2184 x 1690 pixels.
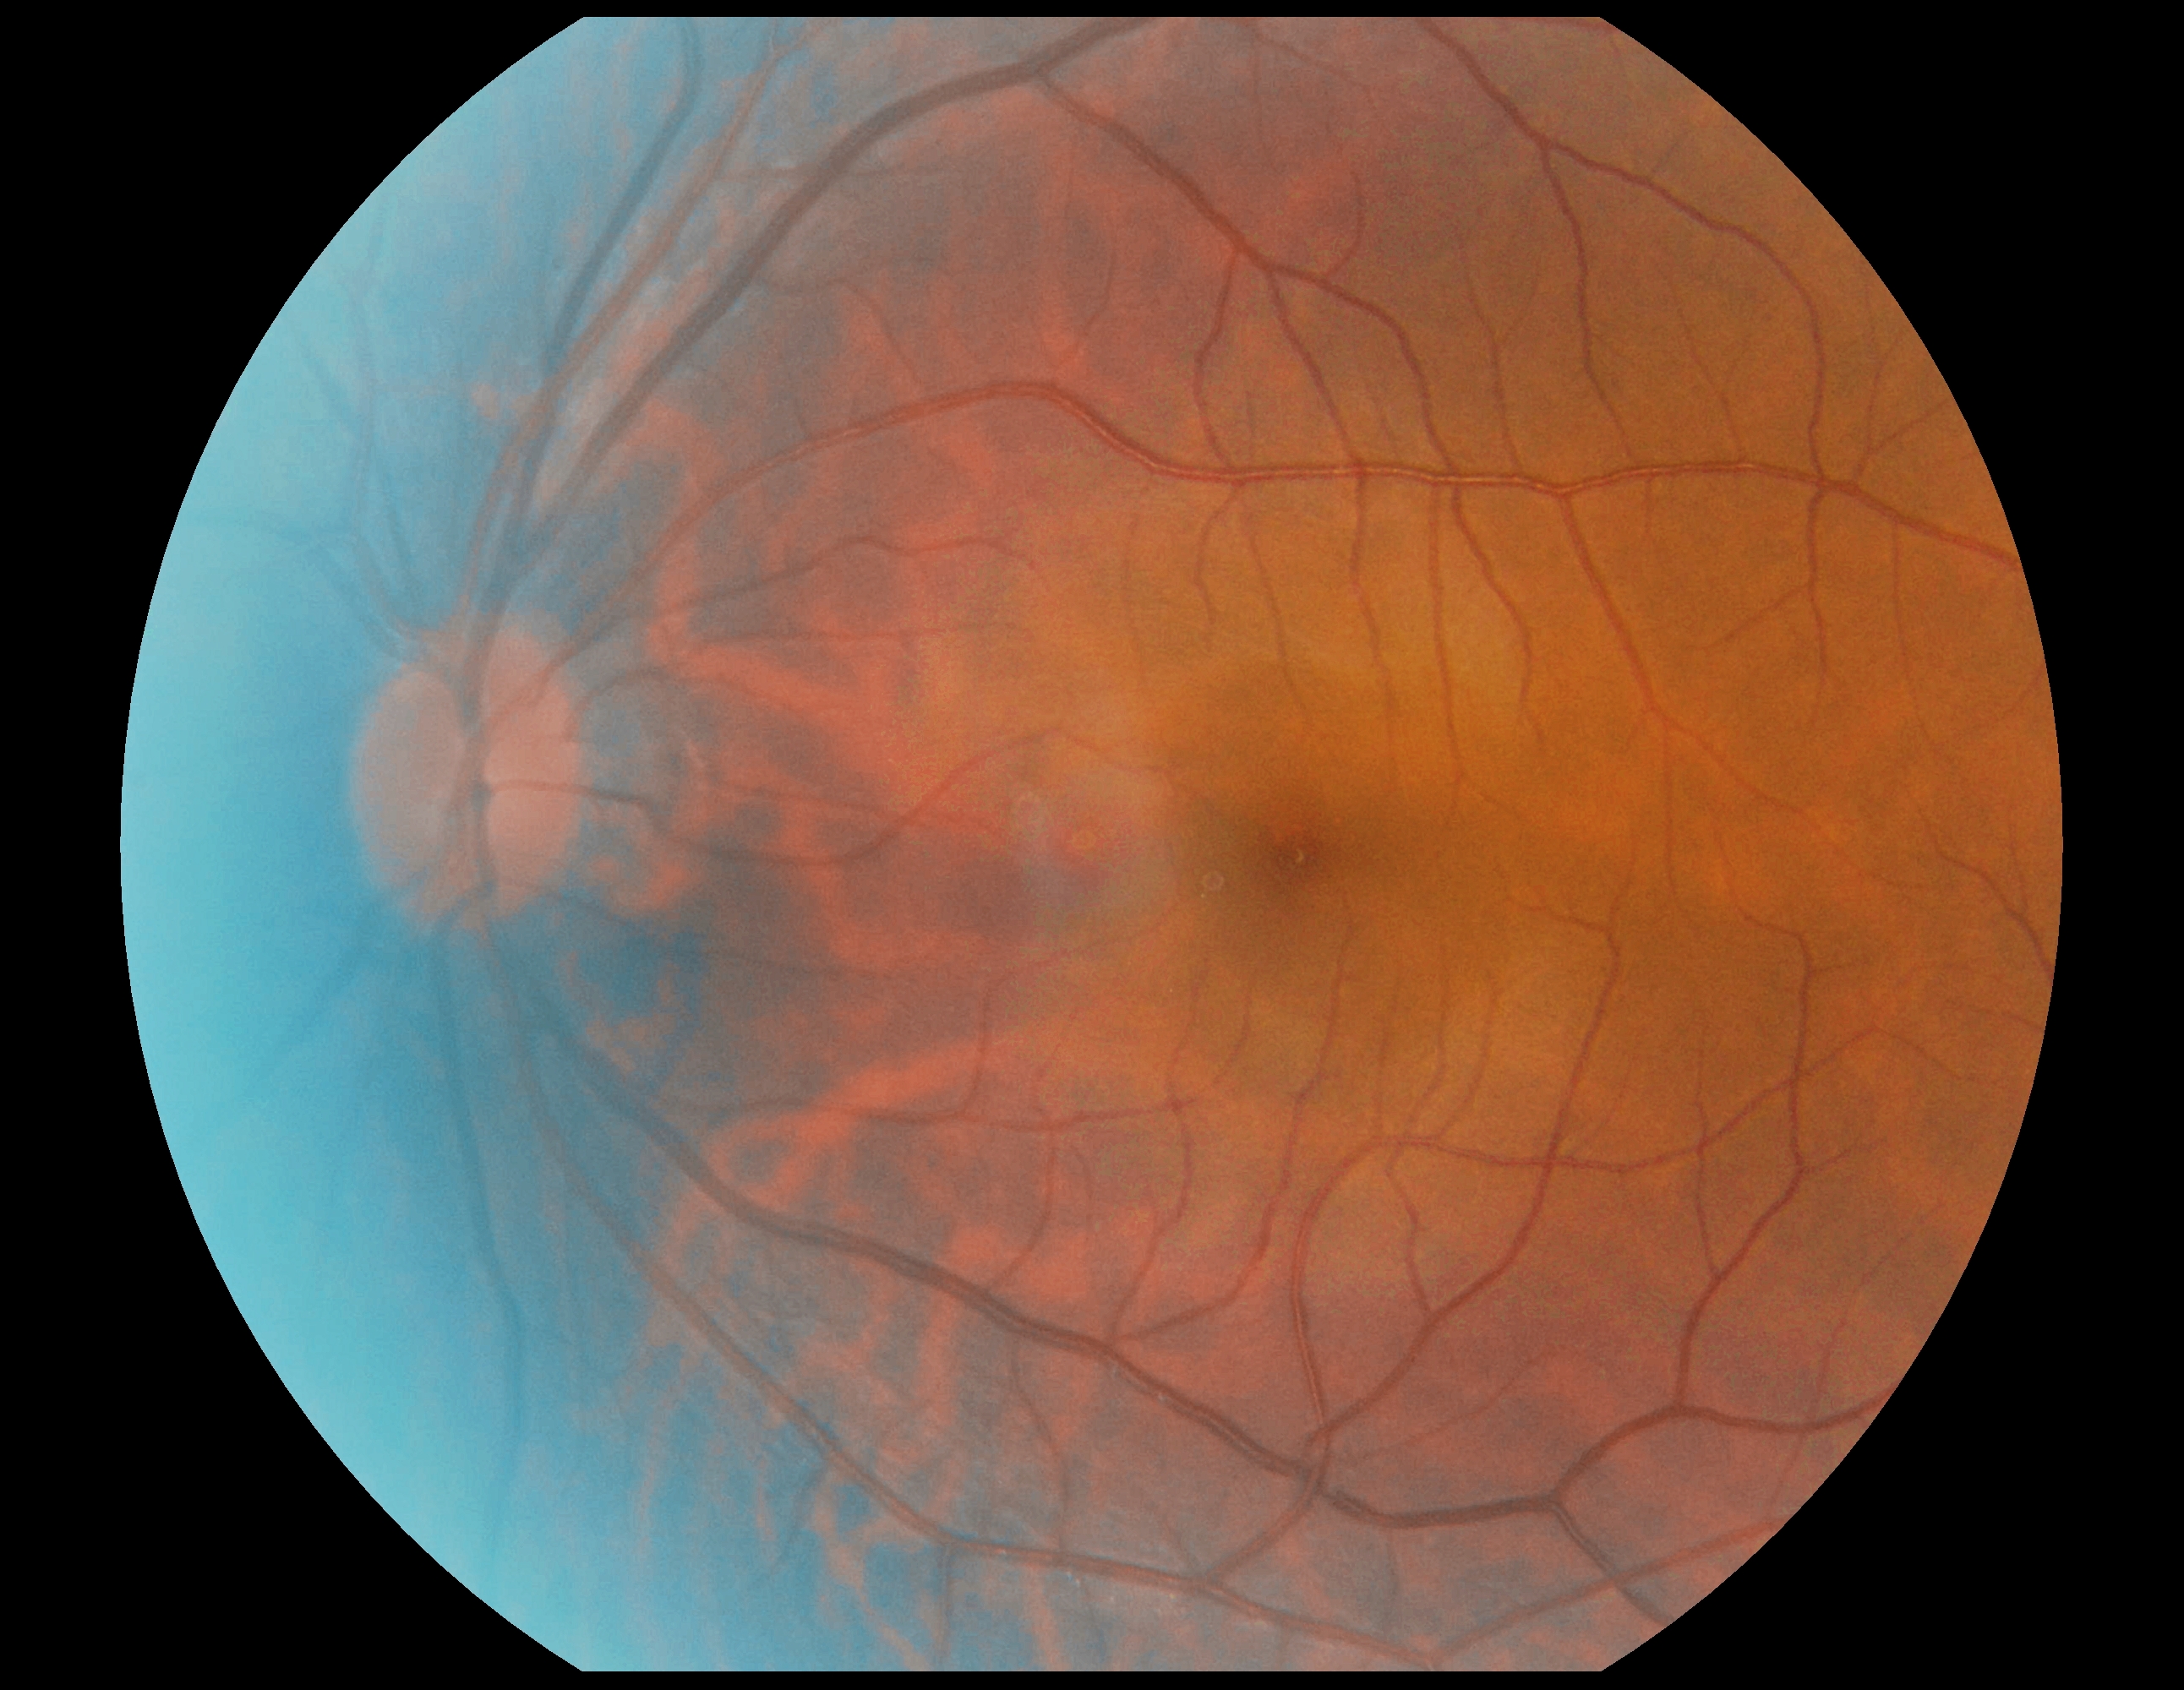
DR is no apparent retinopathy (grade 0) — no visible signs of diabetic retinopathy.